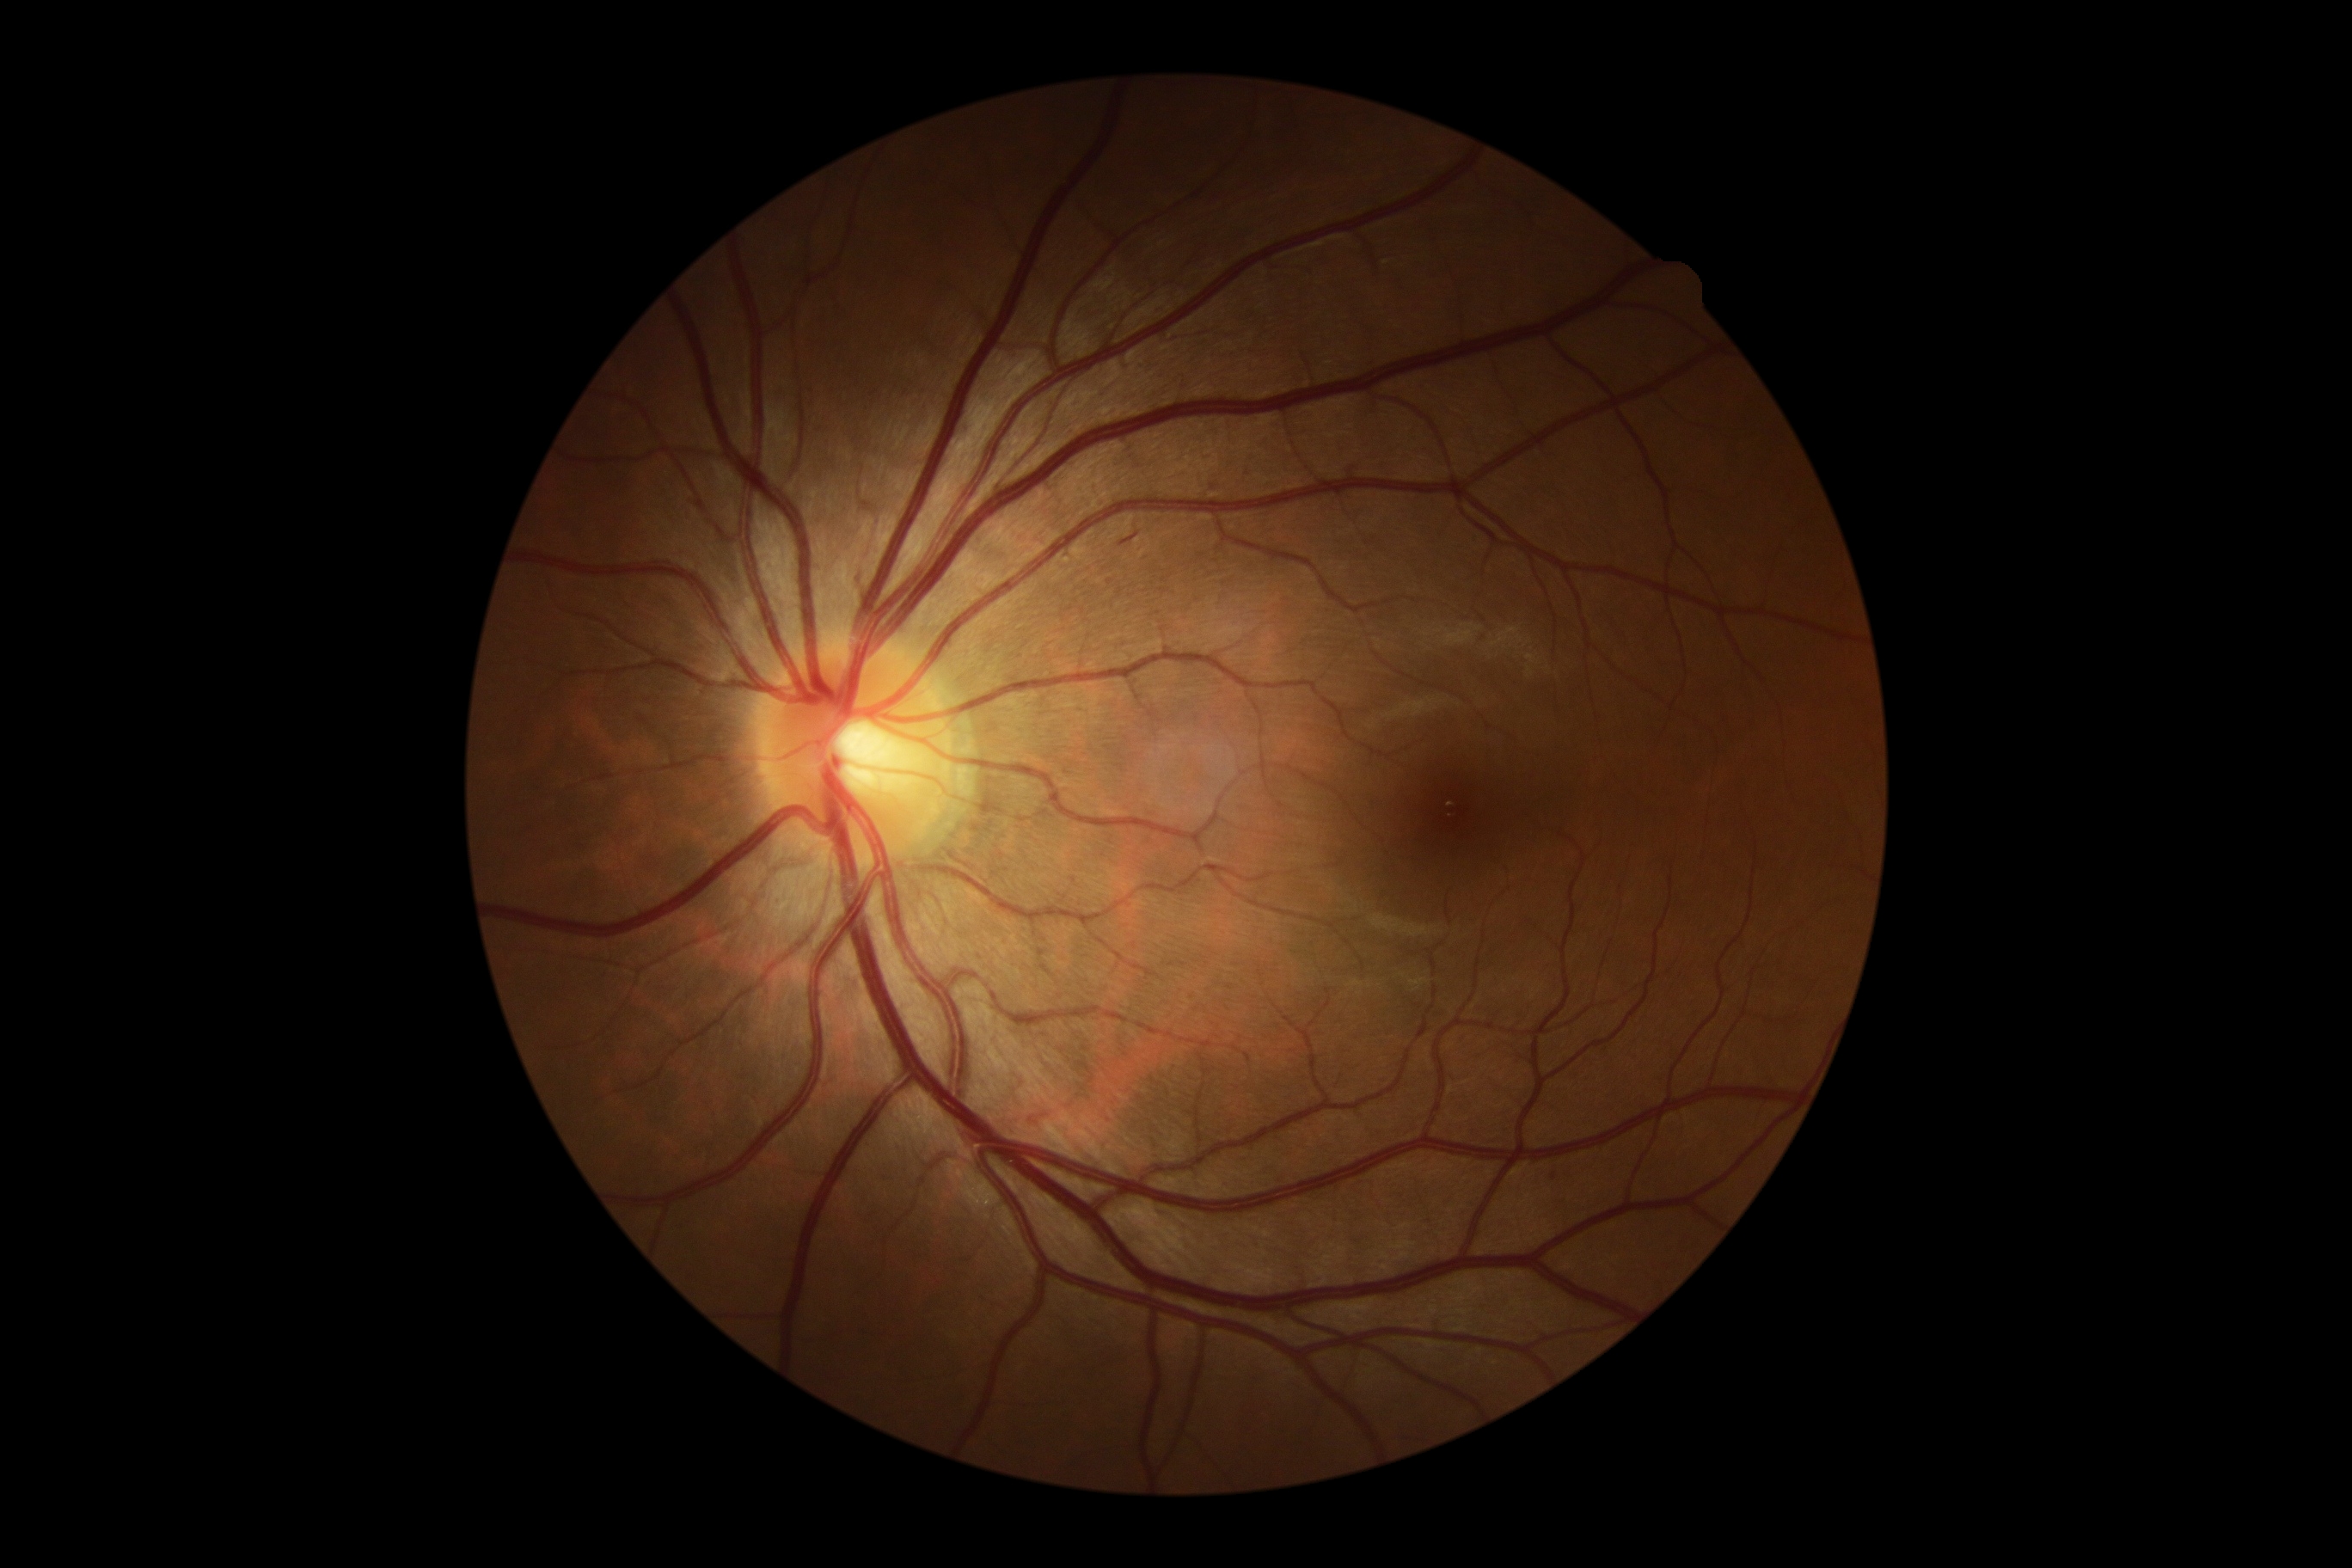

DR class: non-proliferative diabetic retinopathy. Diabetic retinopathy (DR) is moderate non-proliferative diabetic retinopathy (grade 2).